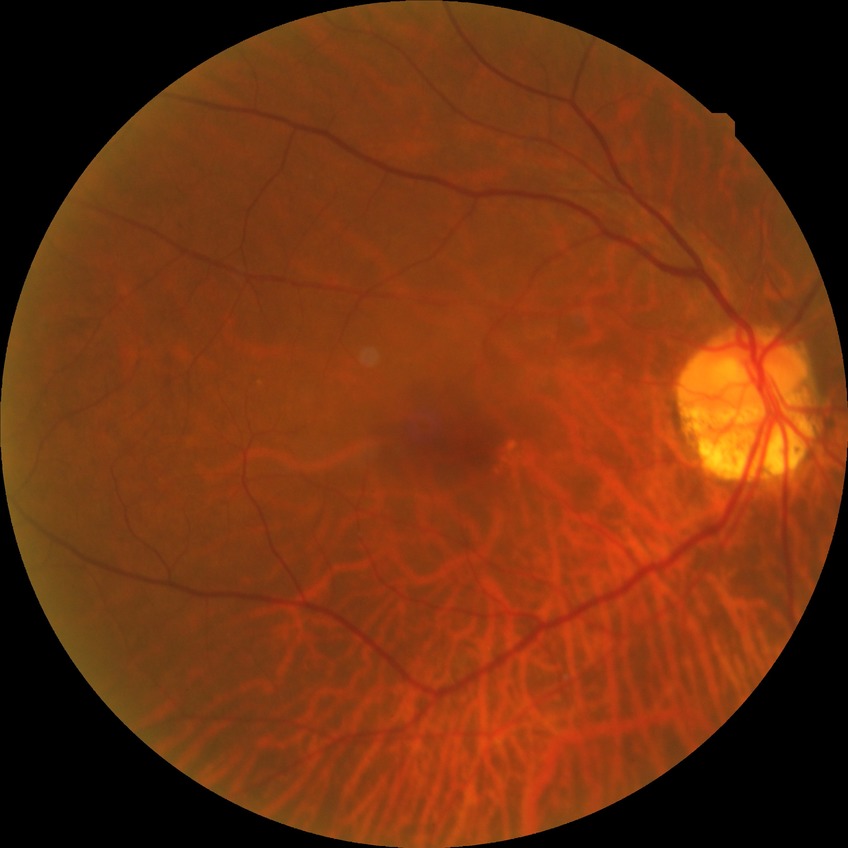
– modified Davis grading — no diabetic retinopathy